2352x1568px: 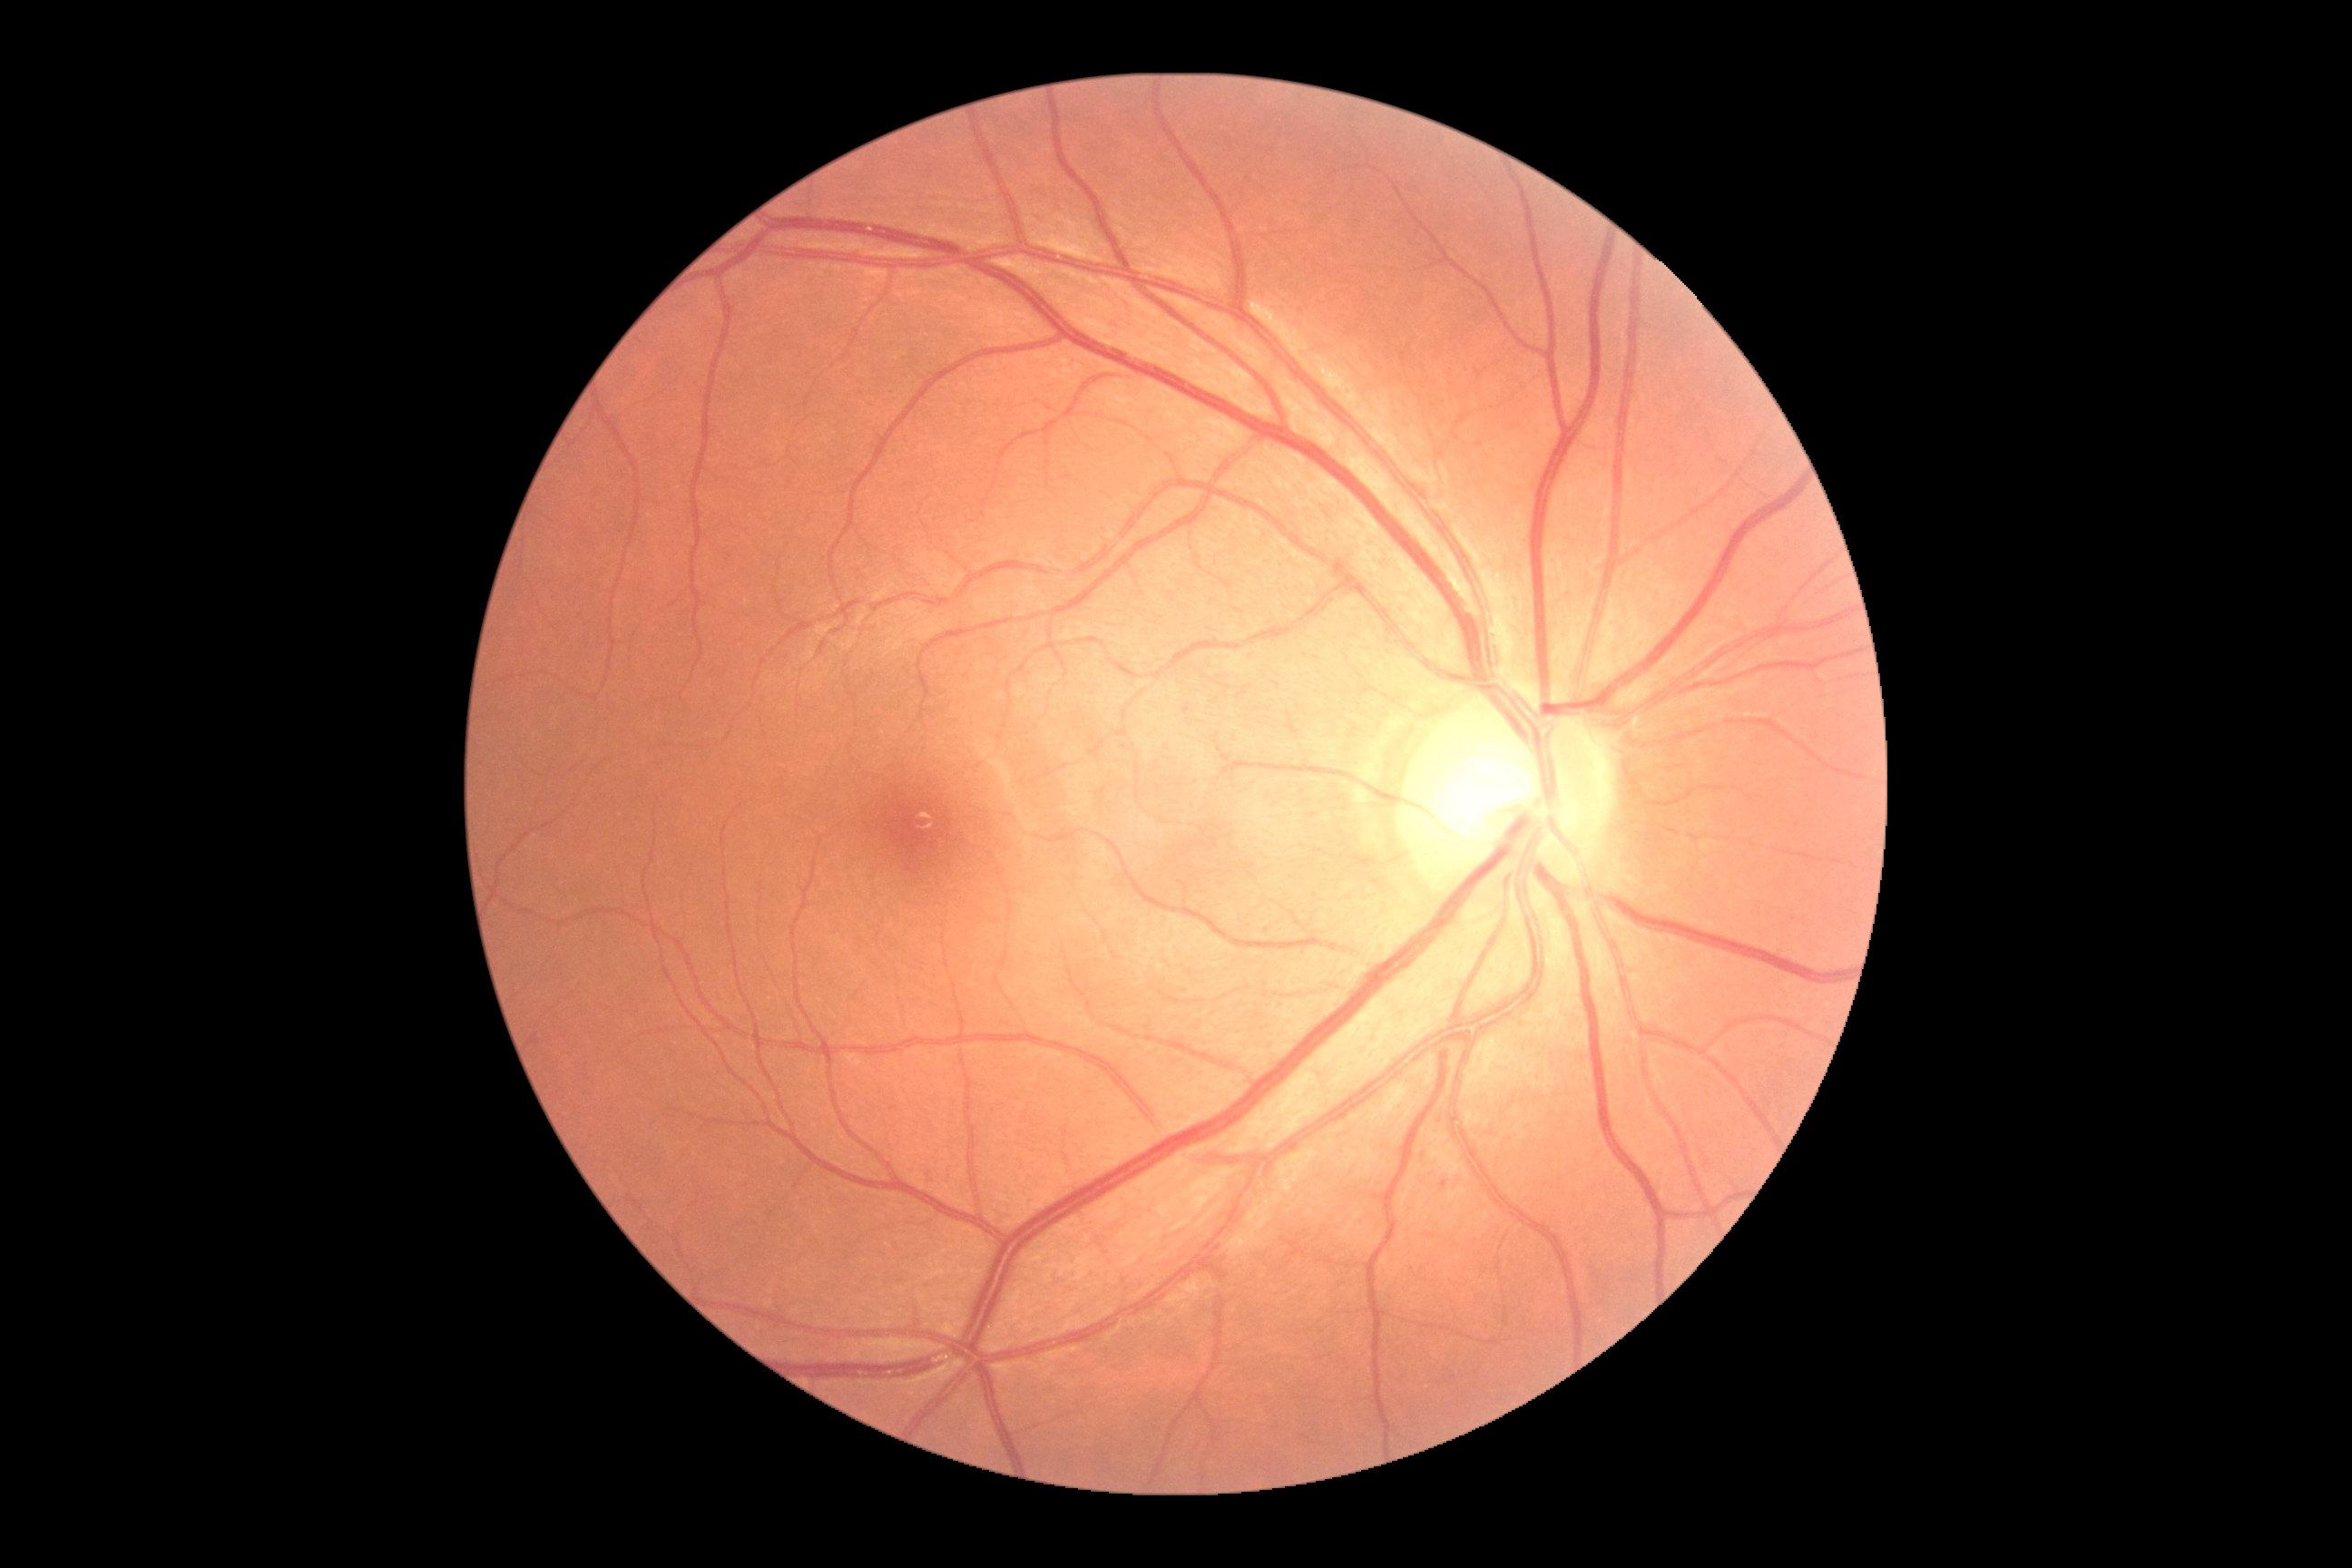

Findings:
- DR: 0/4